Tabletop color fundus camera image · 50° FOV:
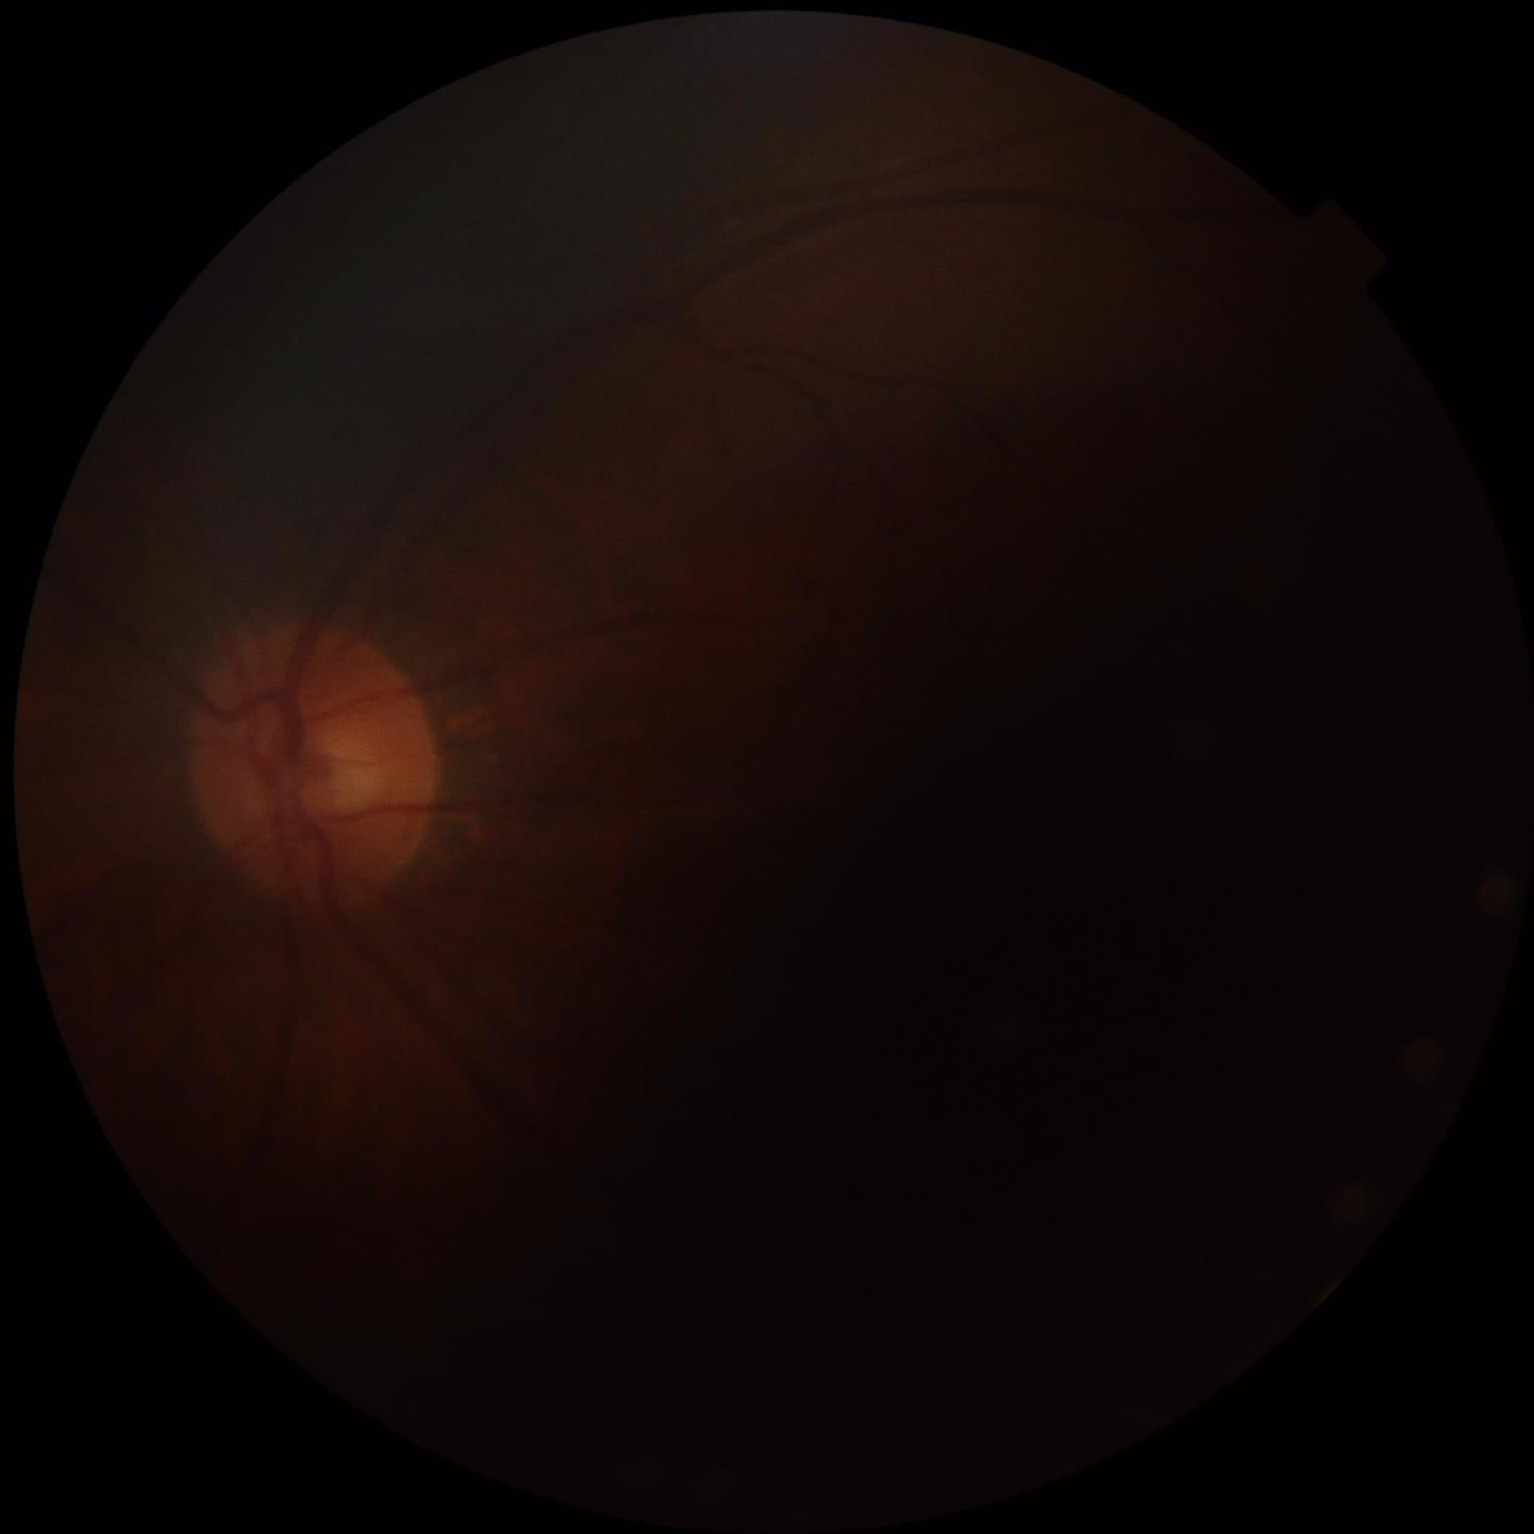 Quality grading:
- focus: out of focus
- illumination: uneven
- overall: suboptimal
- contrast: poor